Pediatric retinal photograph (wide-field). 1240 by 1240 pixels
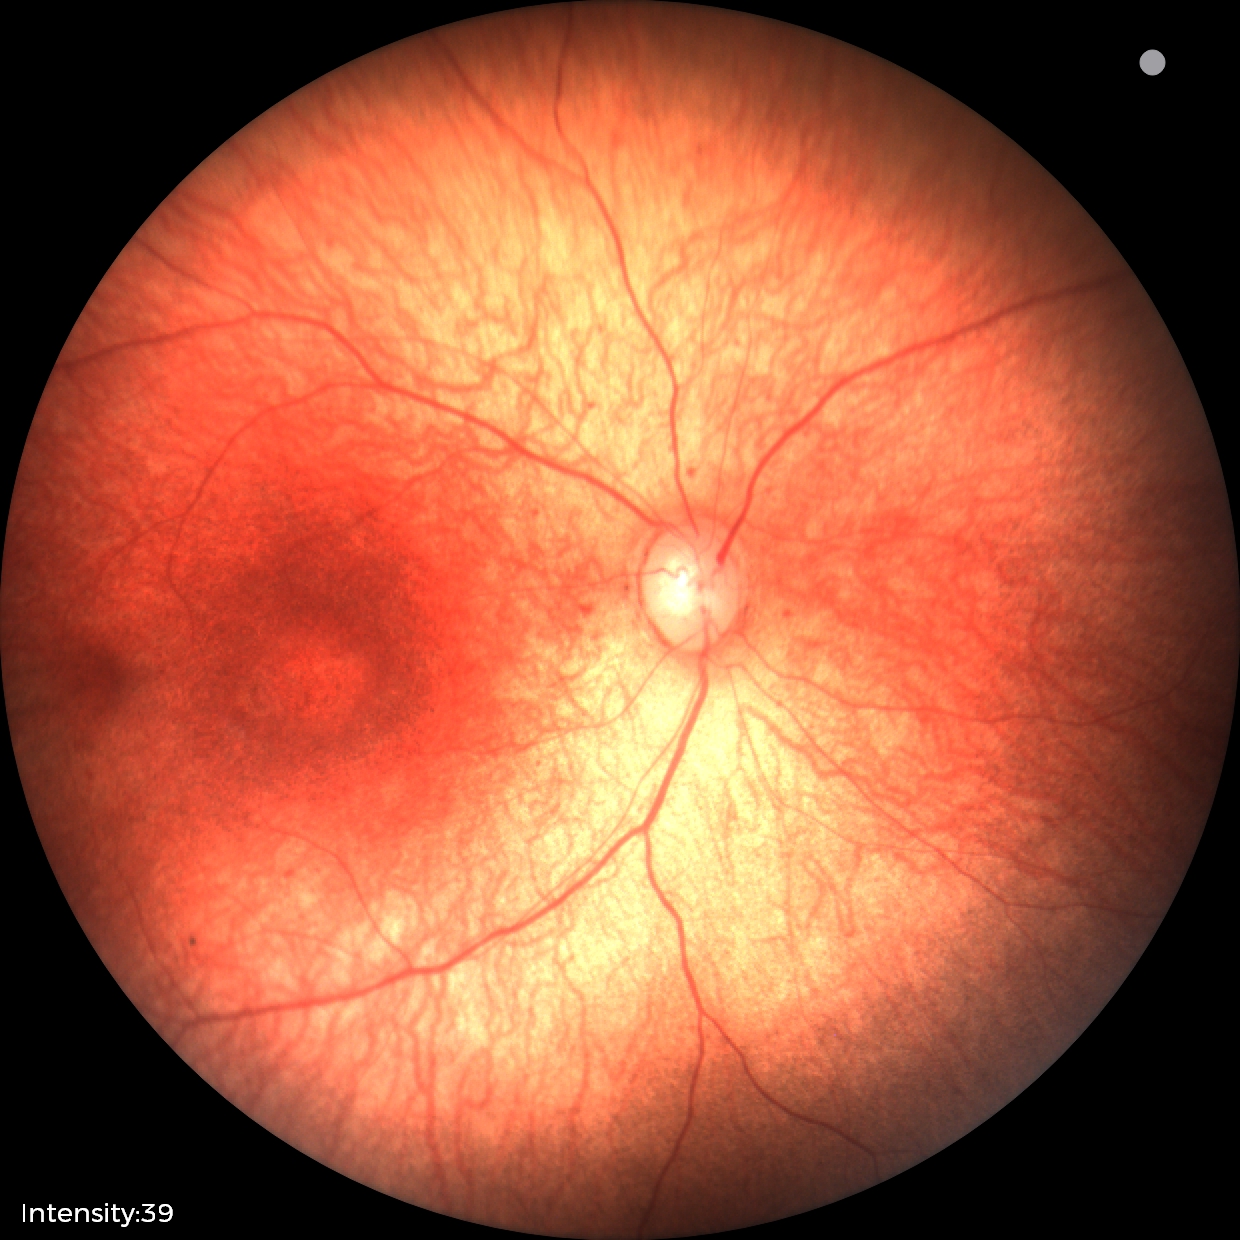 Screening: physiological appearance with no retinal pathology.